Nonmydriatic fundus photograph · 848 by 848 pixels · posterior pole color fundus photograph
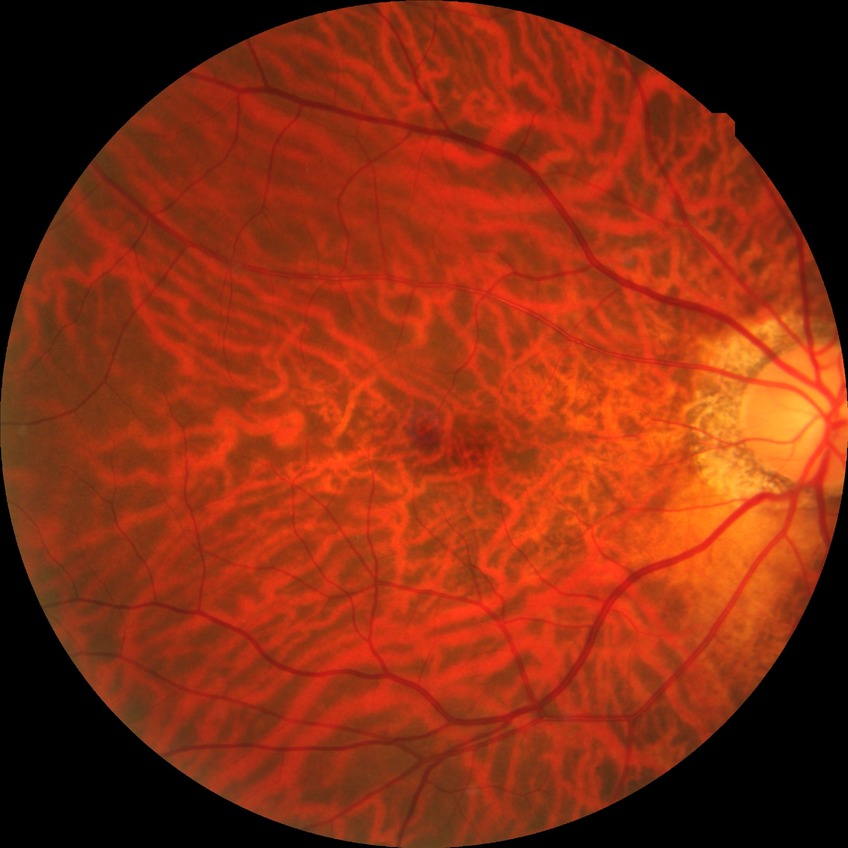 Diabetic retinopathy (DR) is no diabetic retinopathy (NDR).